Nonmydriatic fundus photograph — 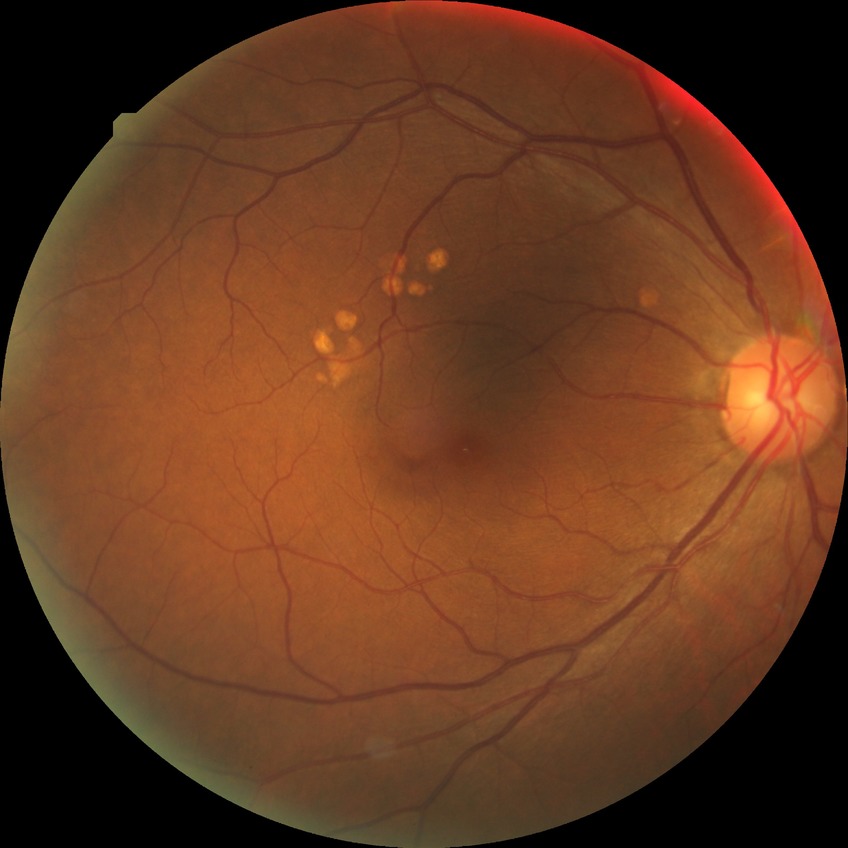
Davis grading: no diabetic retinopathy.